Image size 2352x1568: 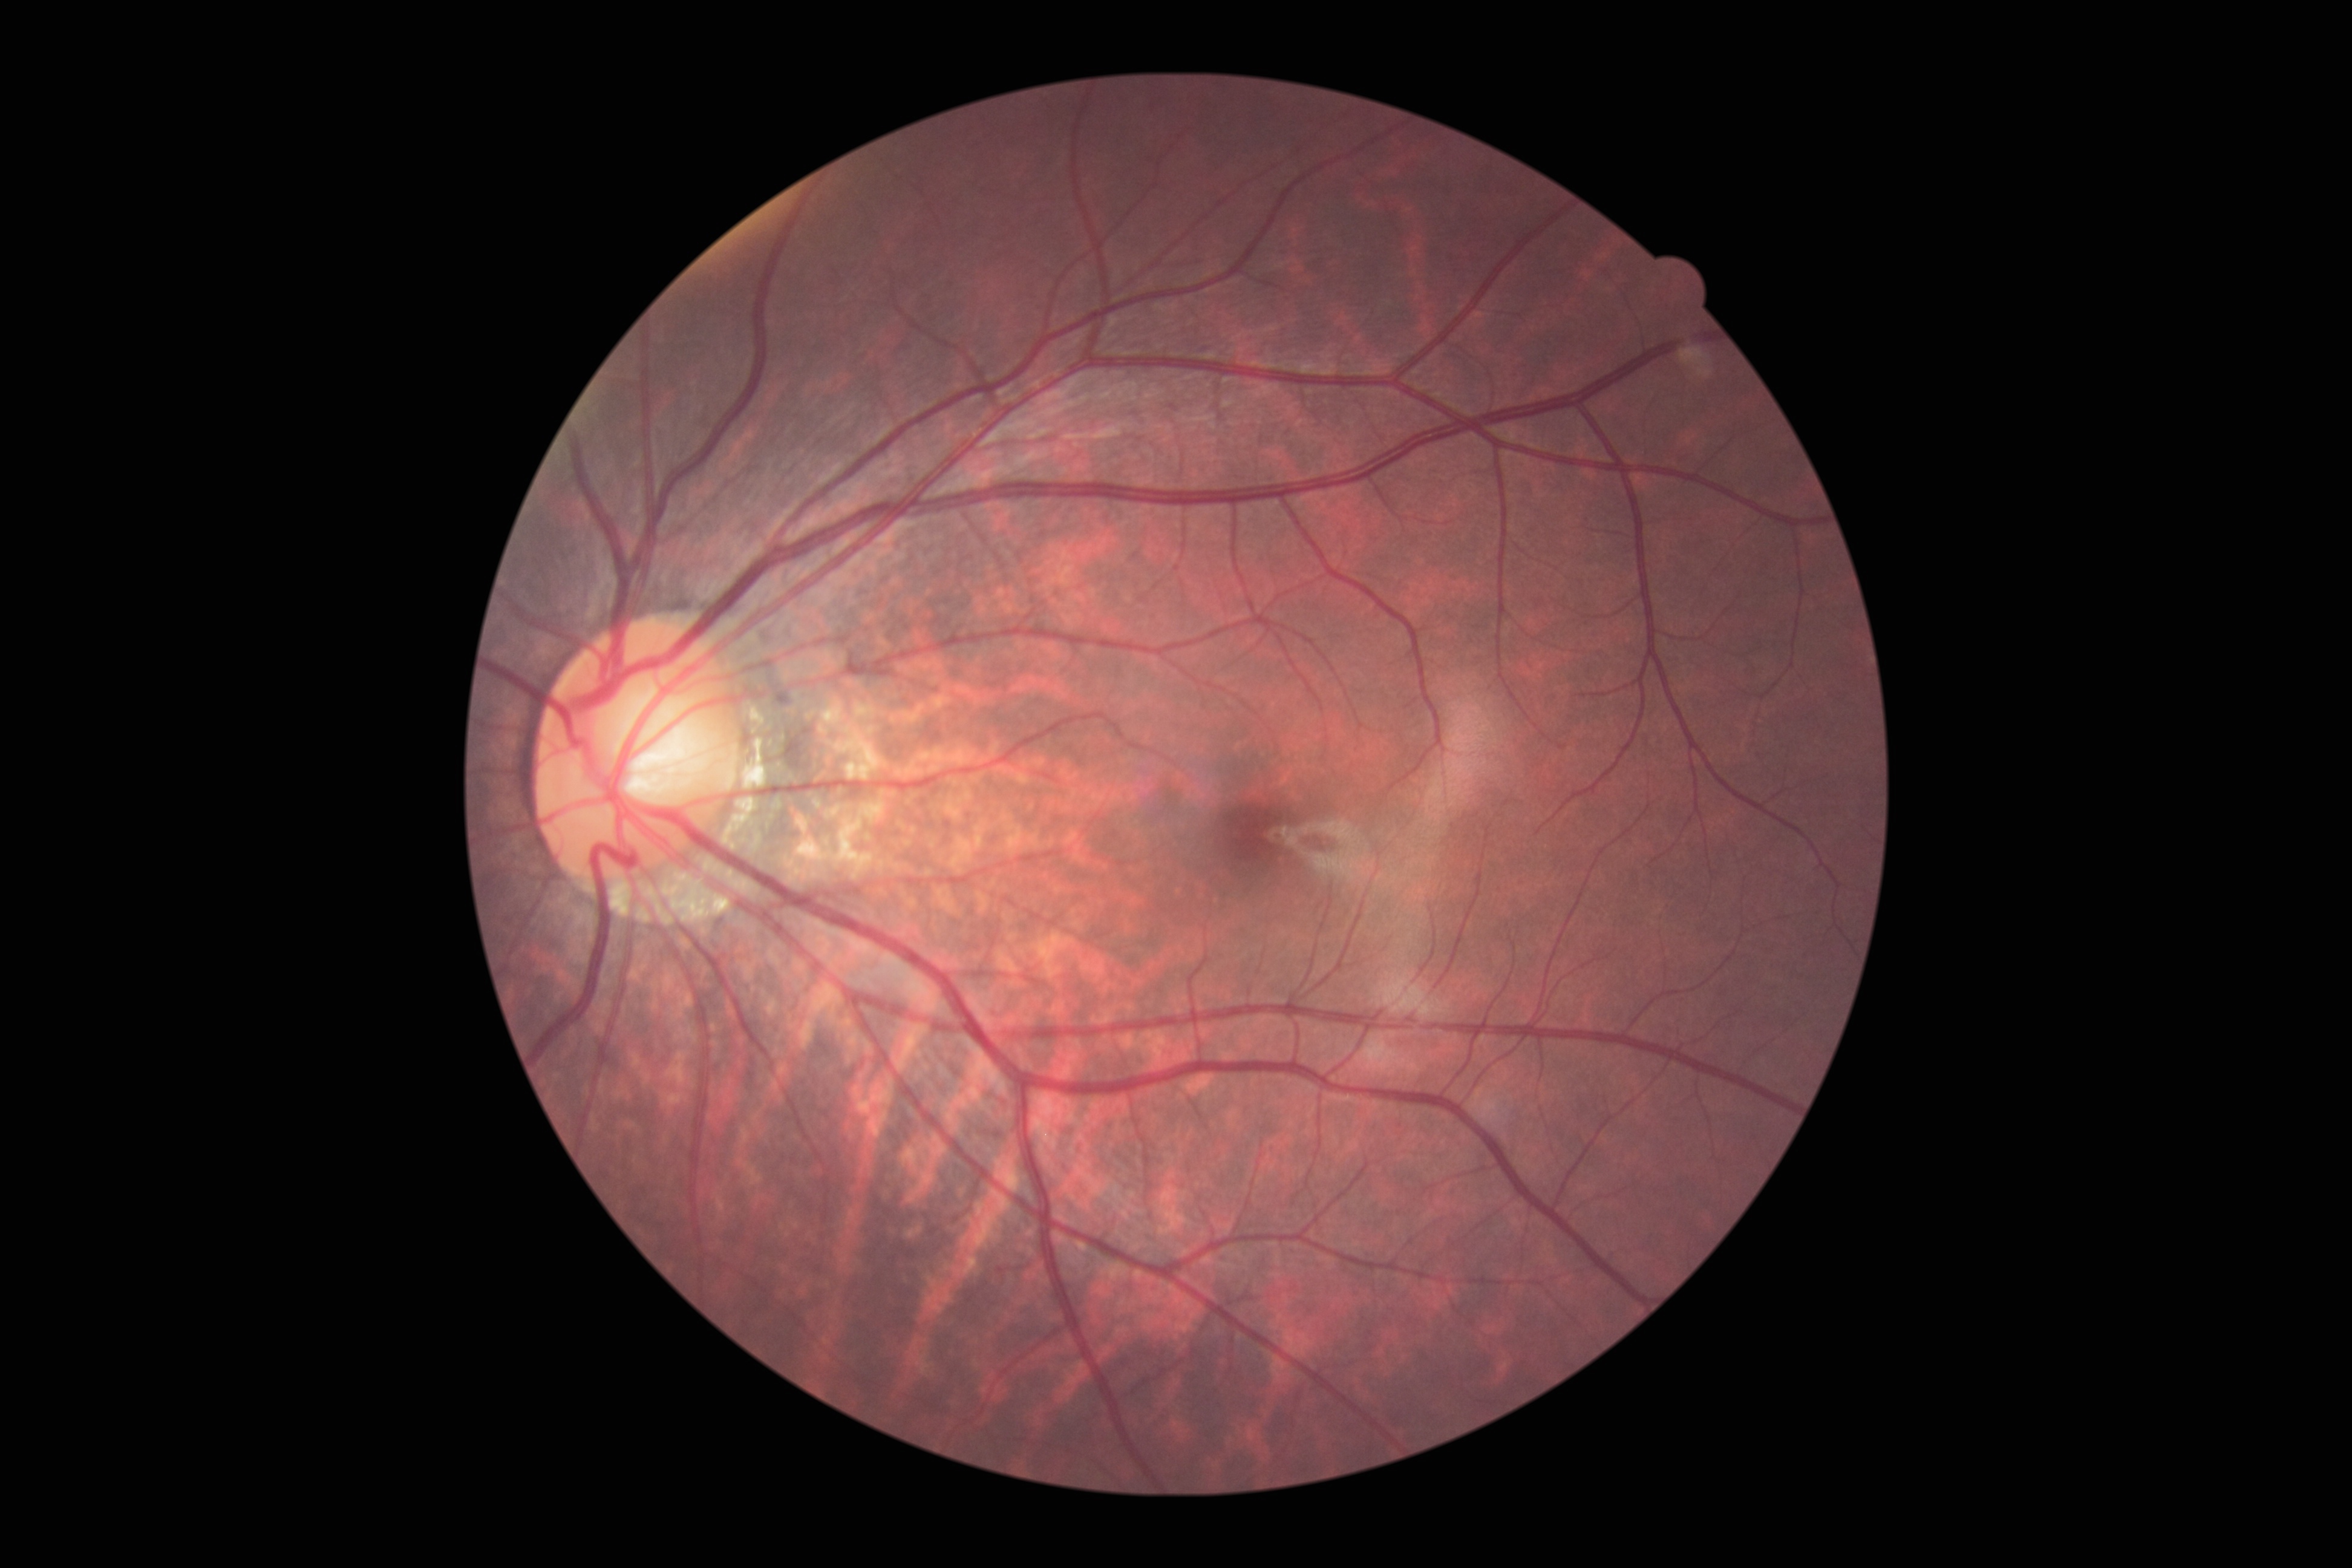
DR grade is no apparent diabetic retinopathy (0).